Retinal fundus photograph: 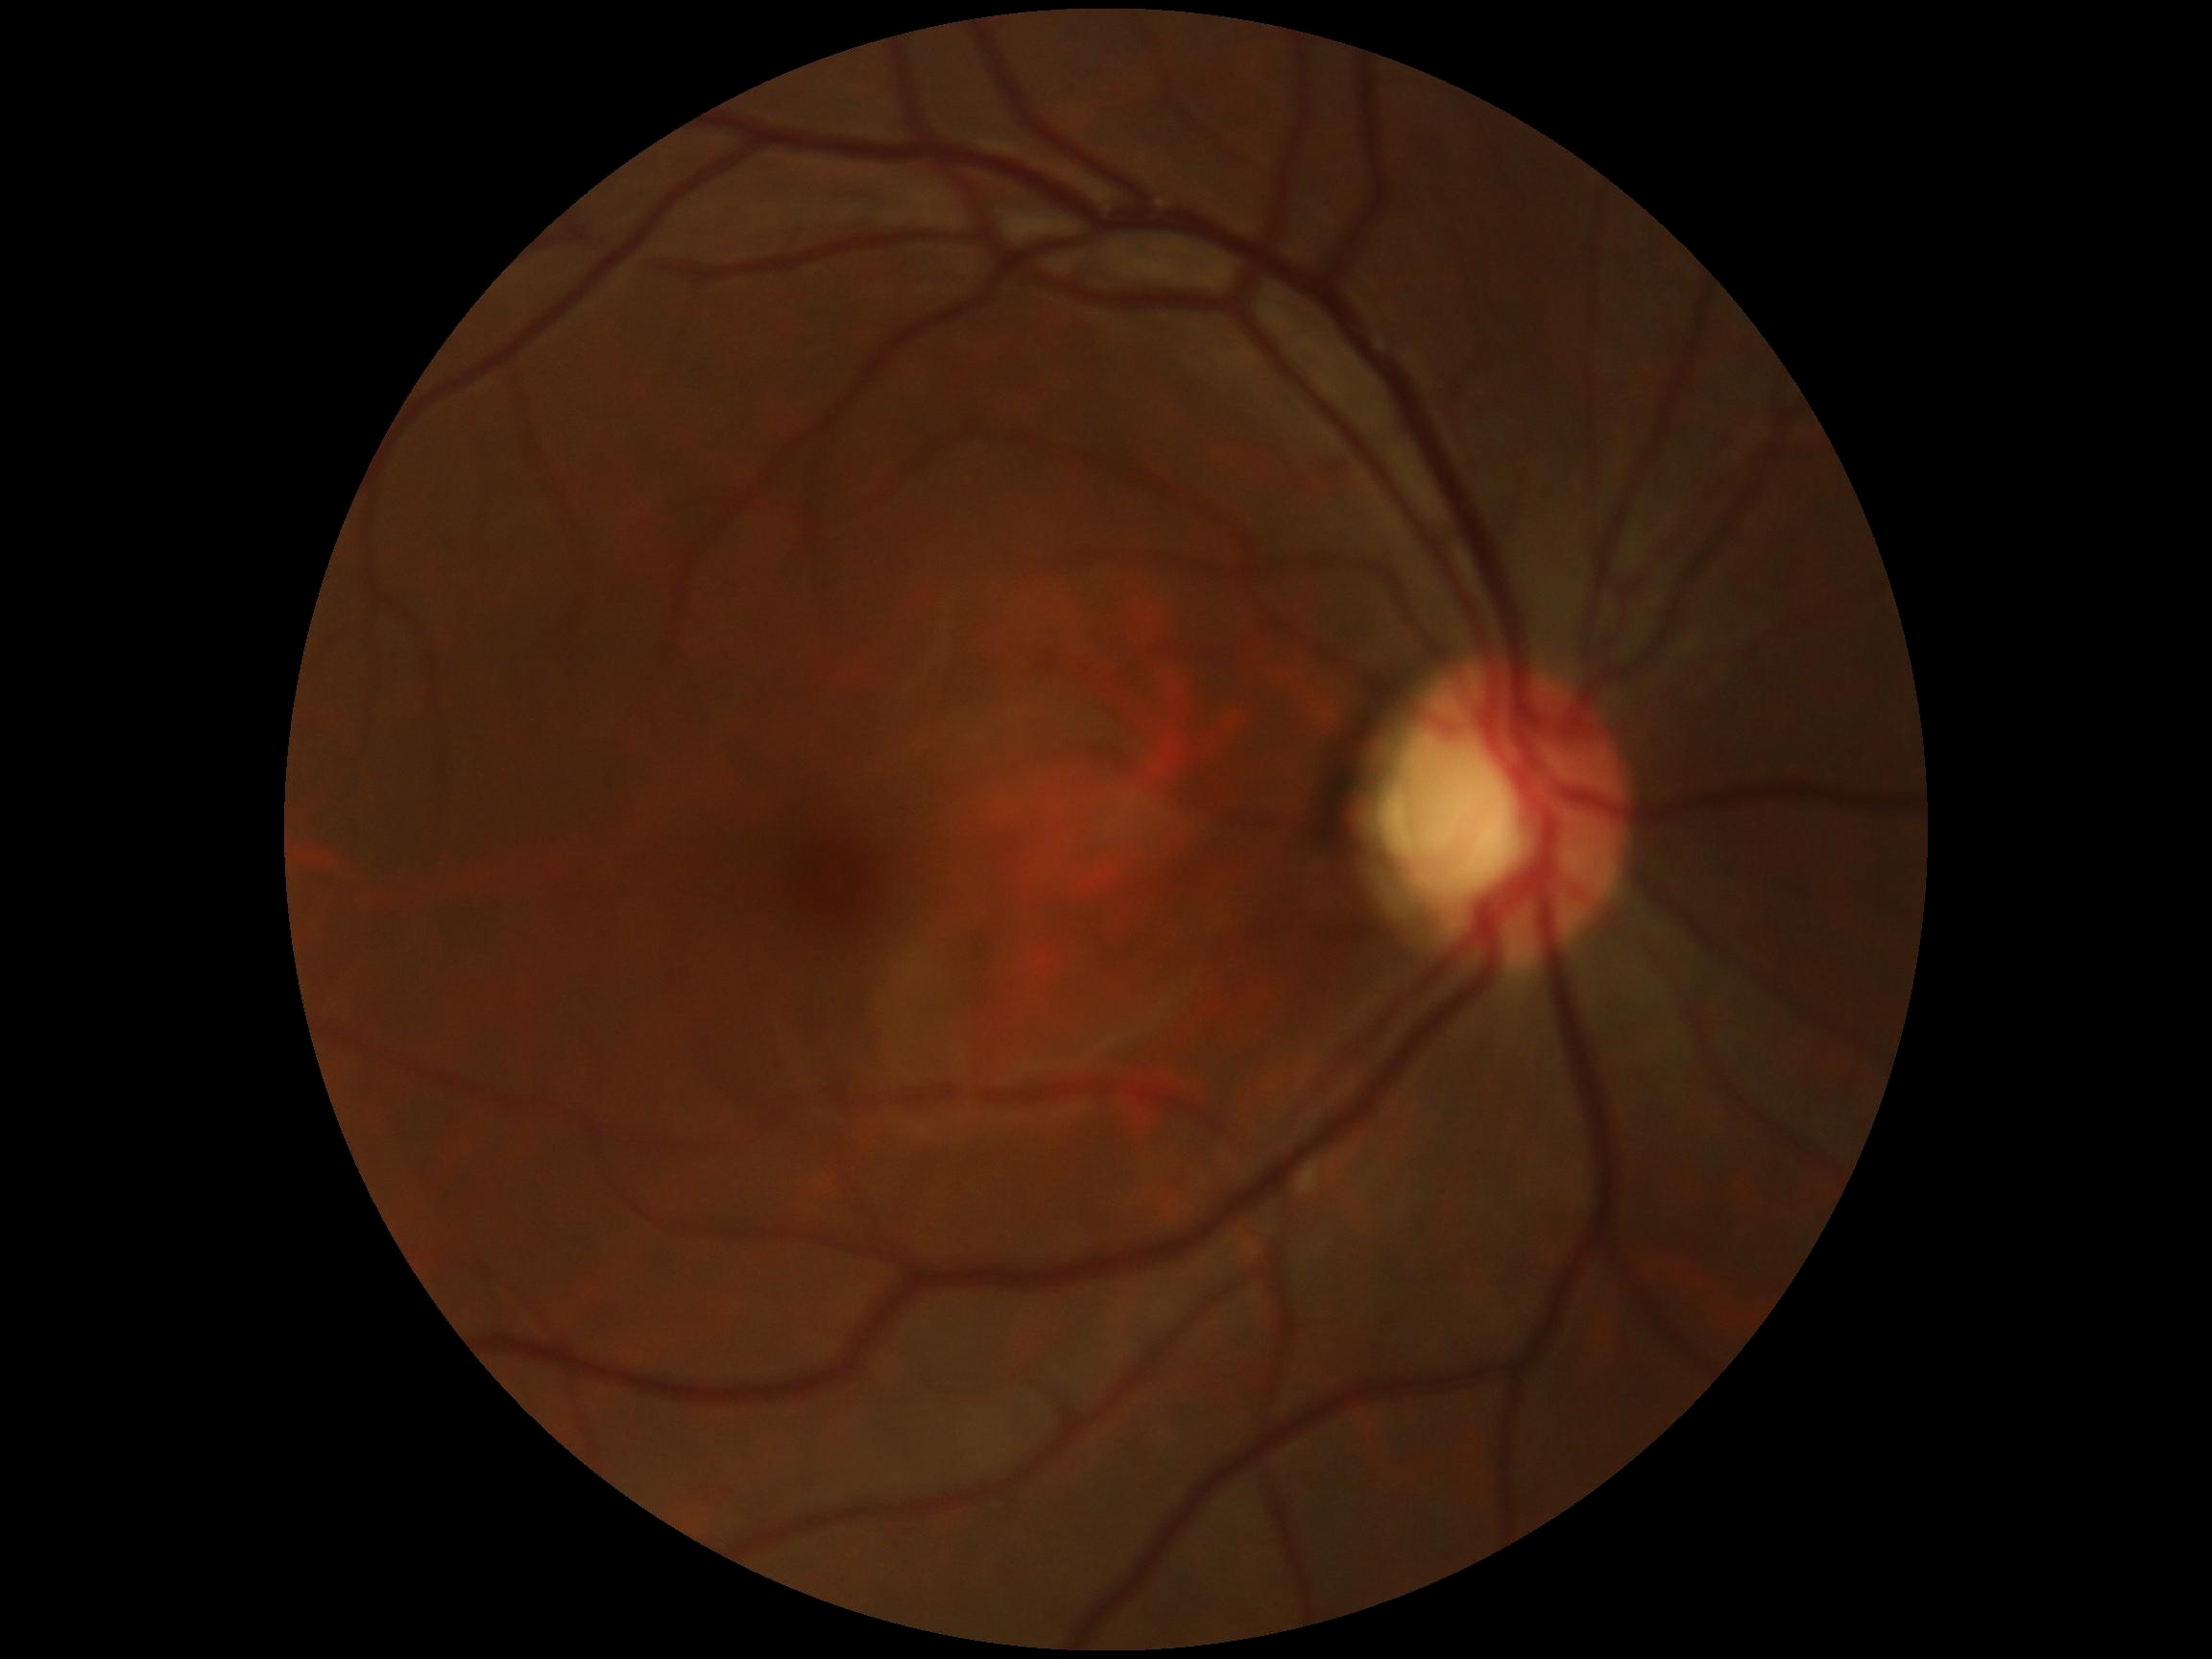

diabetic retinopathy grade: no apparent retinopathy (0).